848x848px, 45 degree fundus photograph — 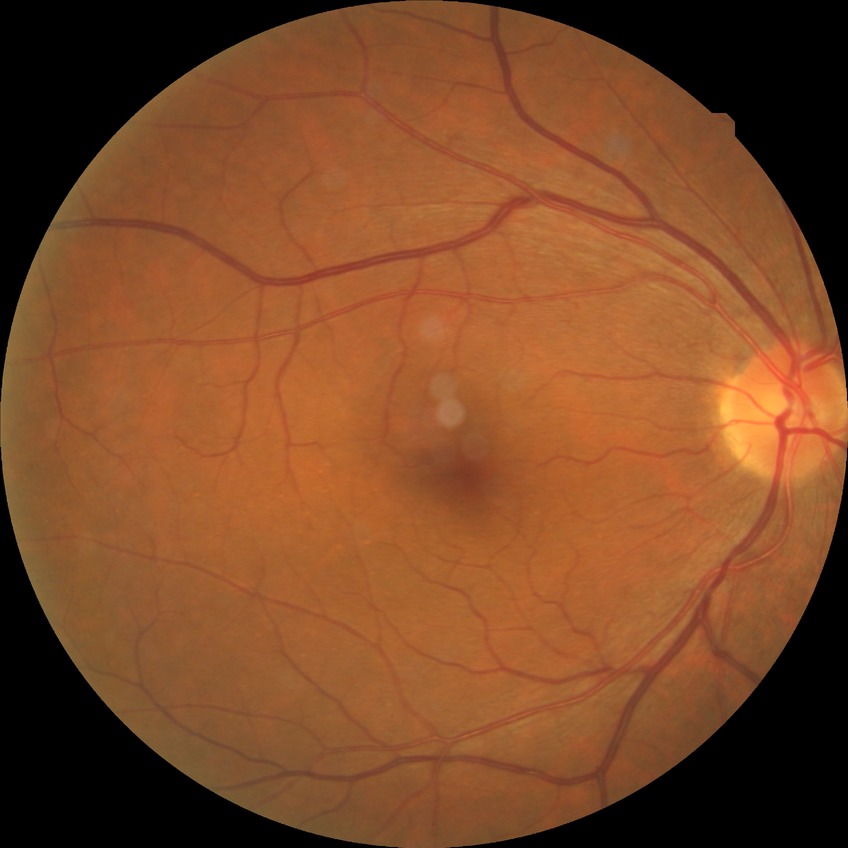
No diabetic retinal disease findings.
DR severity: NDR.